Phoenix ICON wide-field infant fundus image.
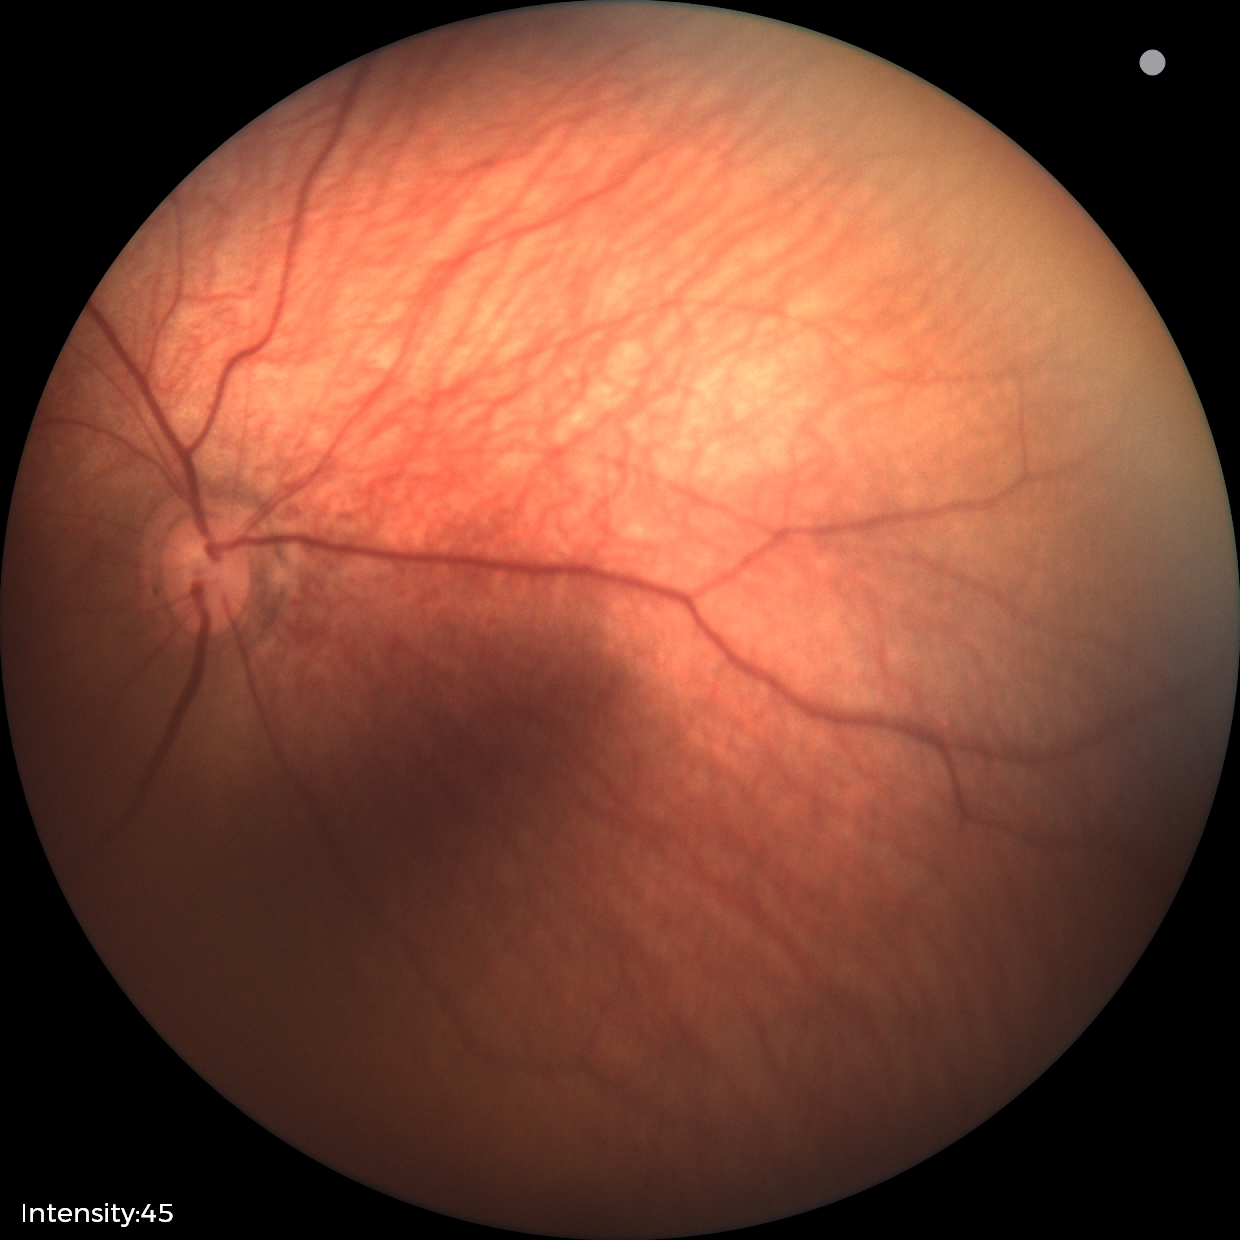 Assessment: normal retinal appearance.